Posterior pole field covering the optic disc and macula · 2228x1652 · retinal fundus photograph:
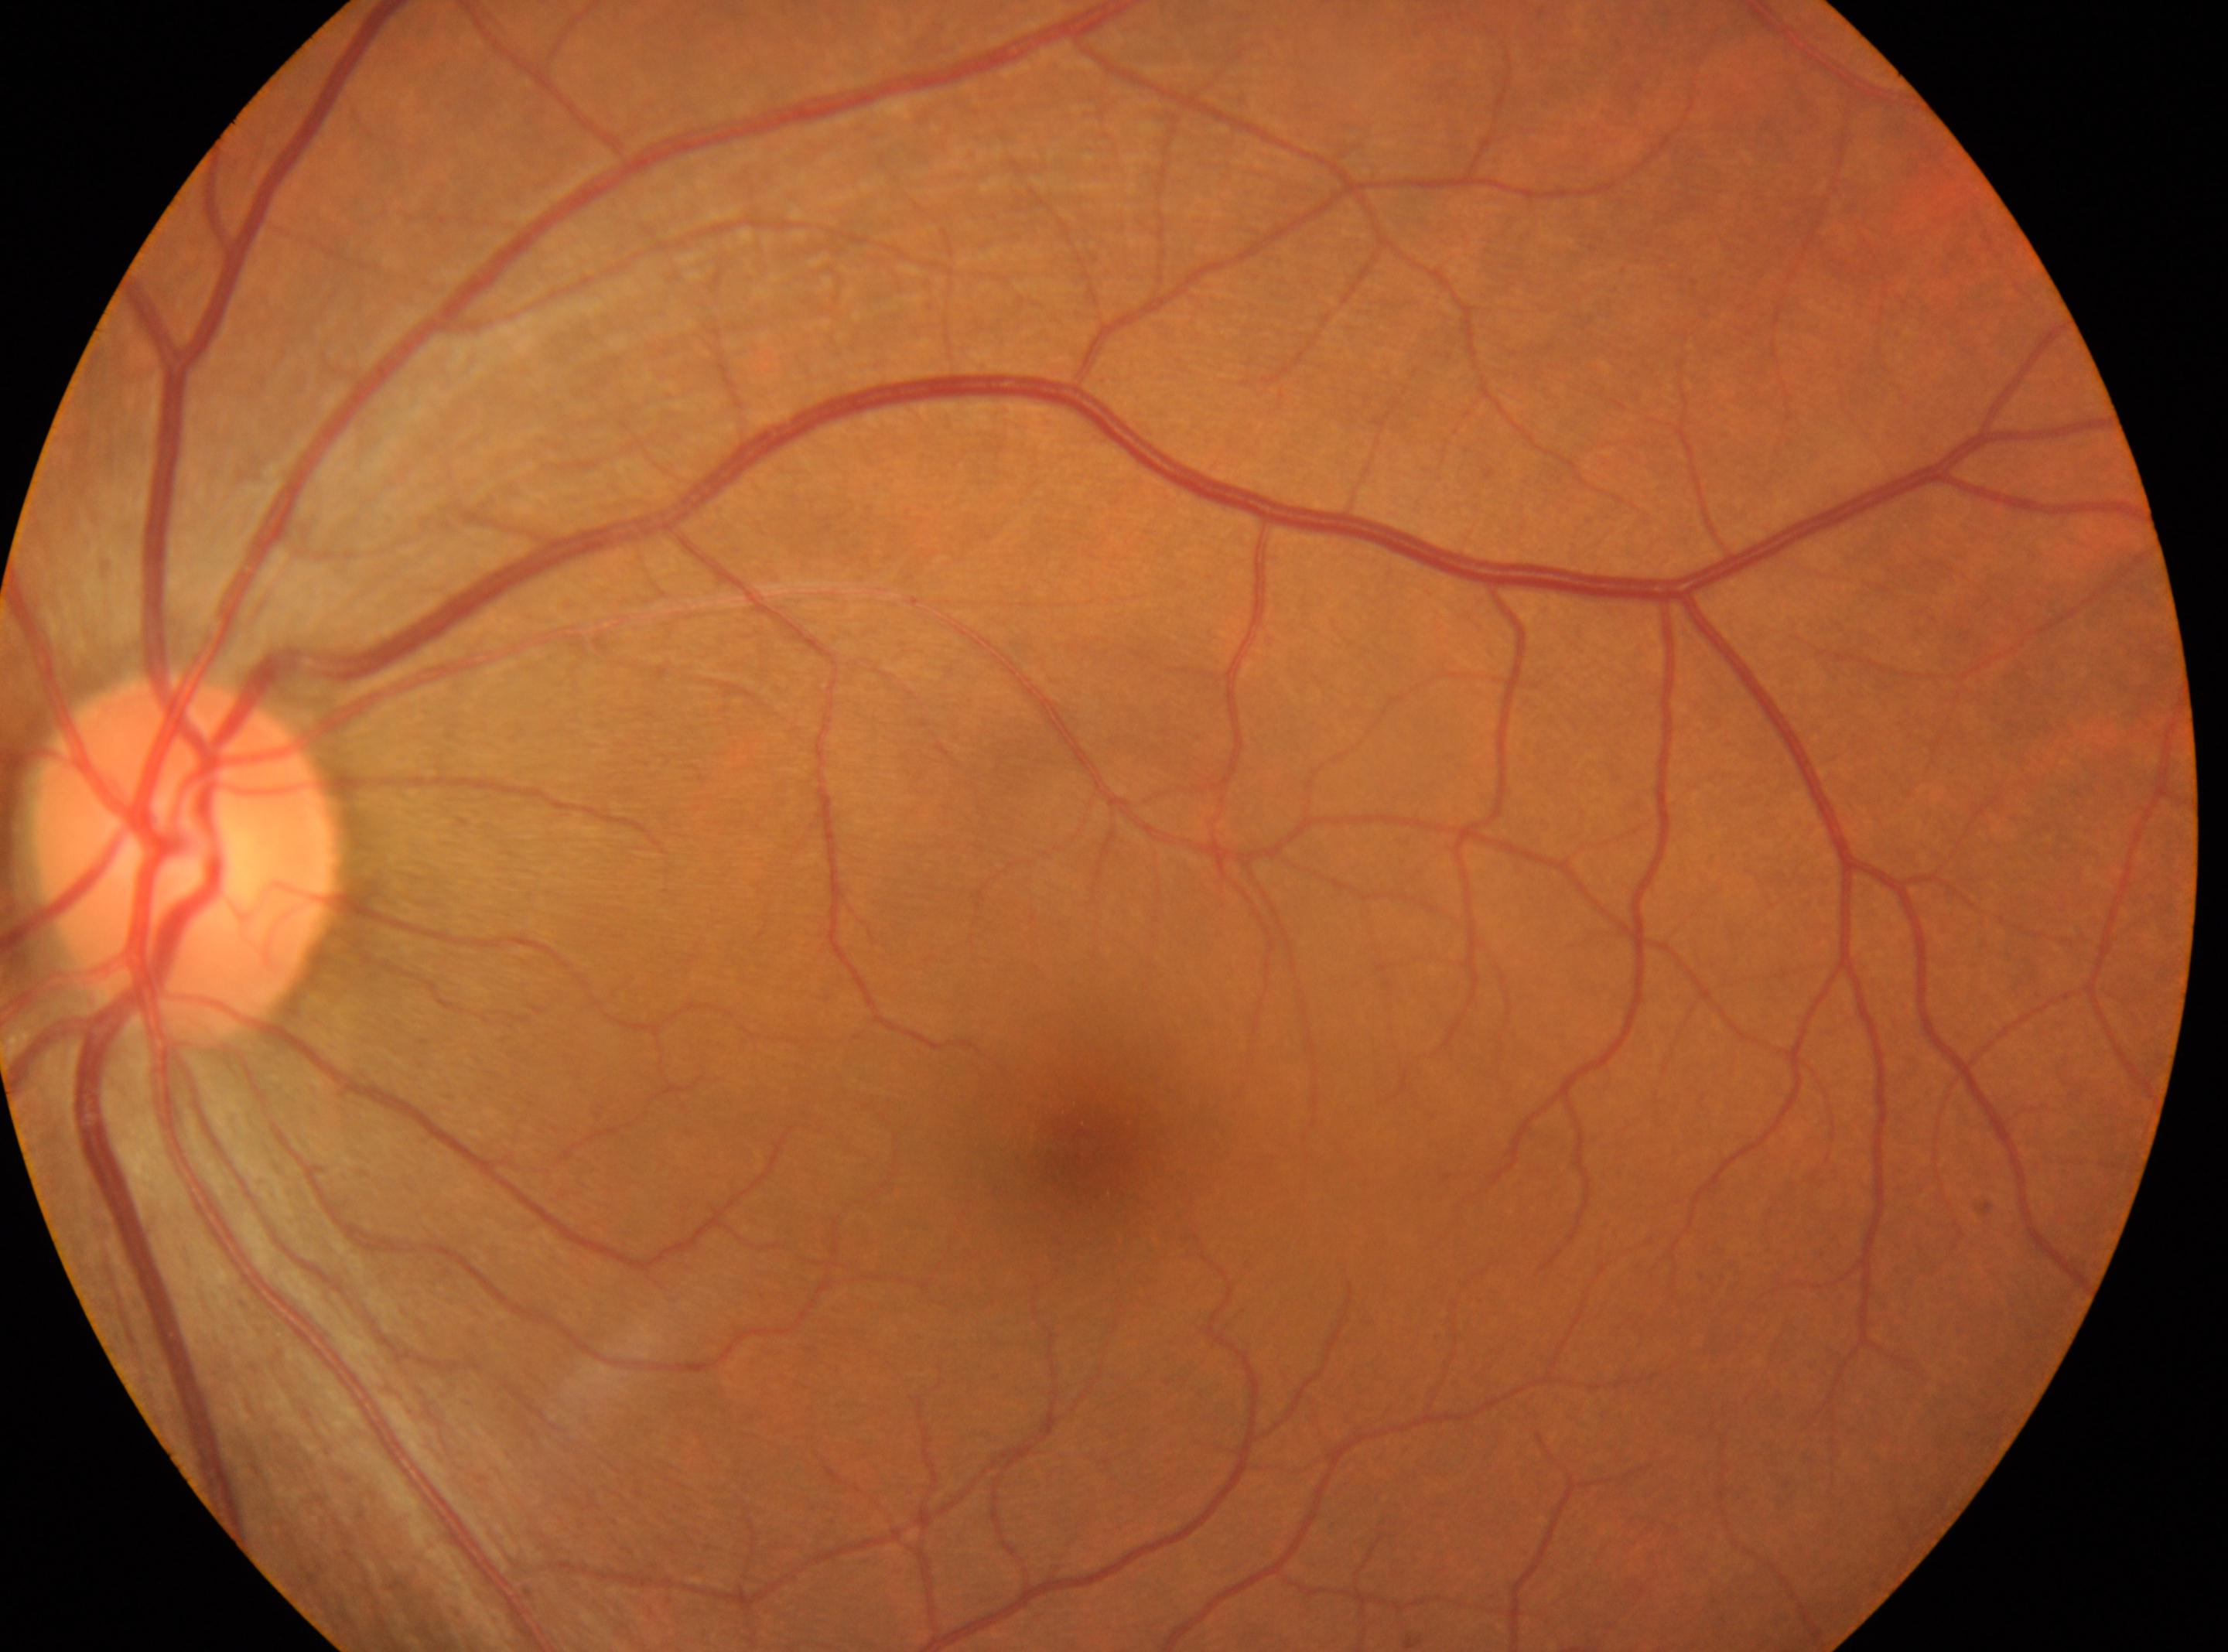

Q: DR stage?
A: 0/4
Q: What is the laterality?
A: left
Q: Locate the fovea.
A: 1085, 1148
Q: Where is the optic disc?
A: 186, 863